45° FOV.
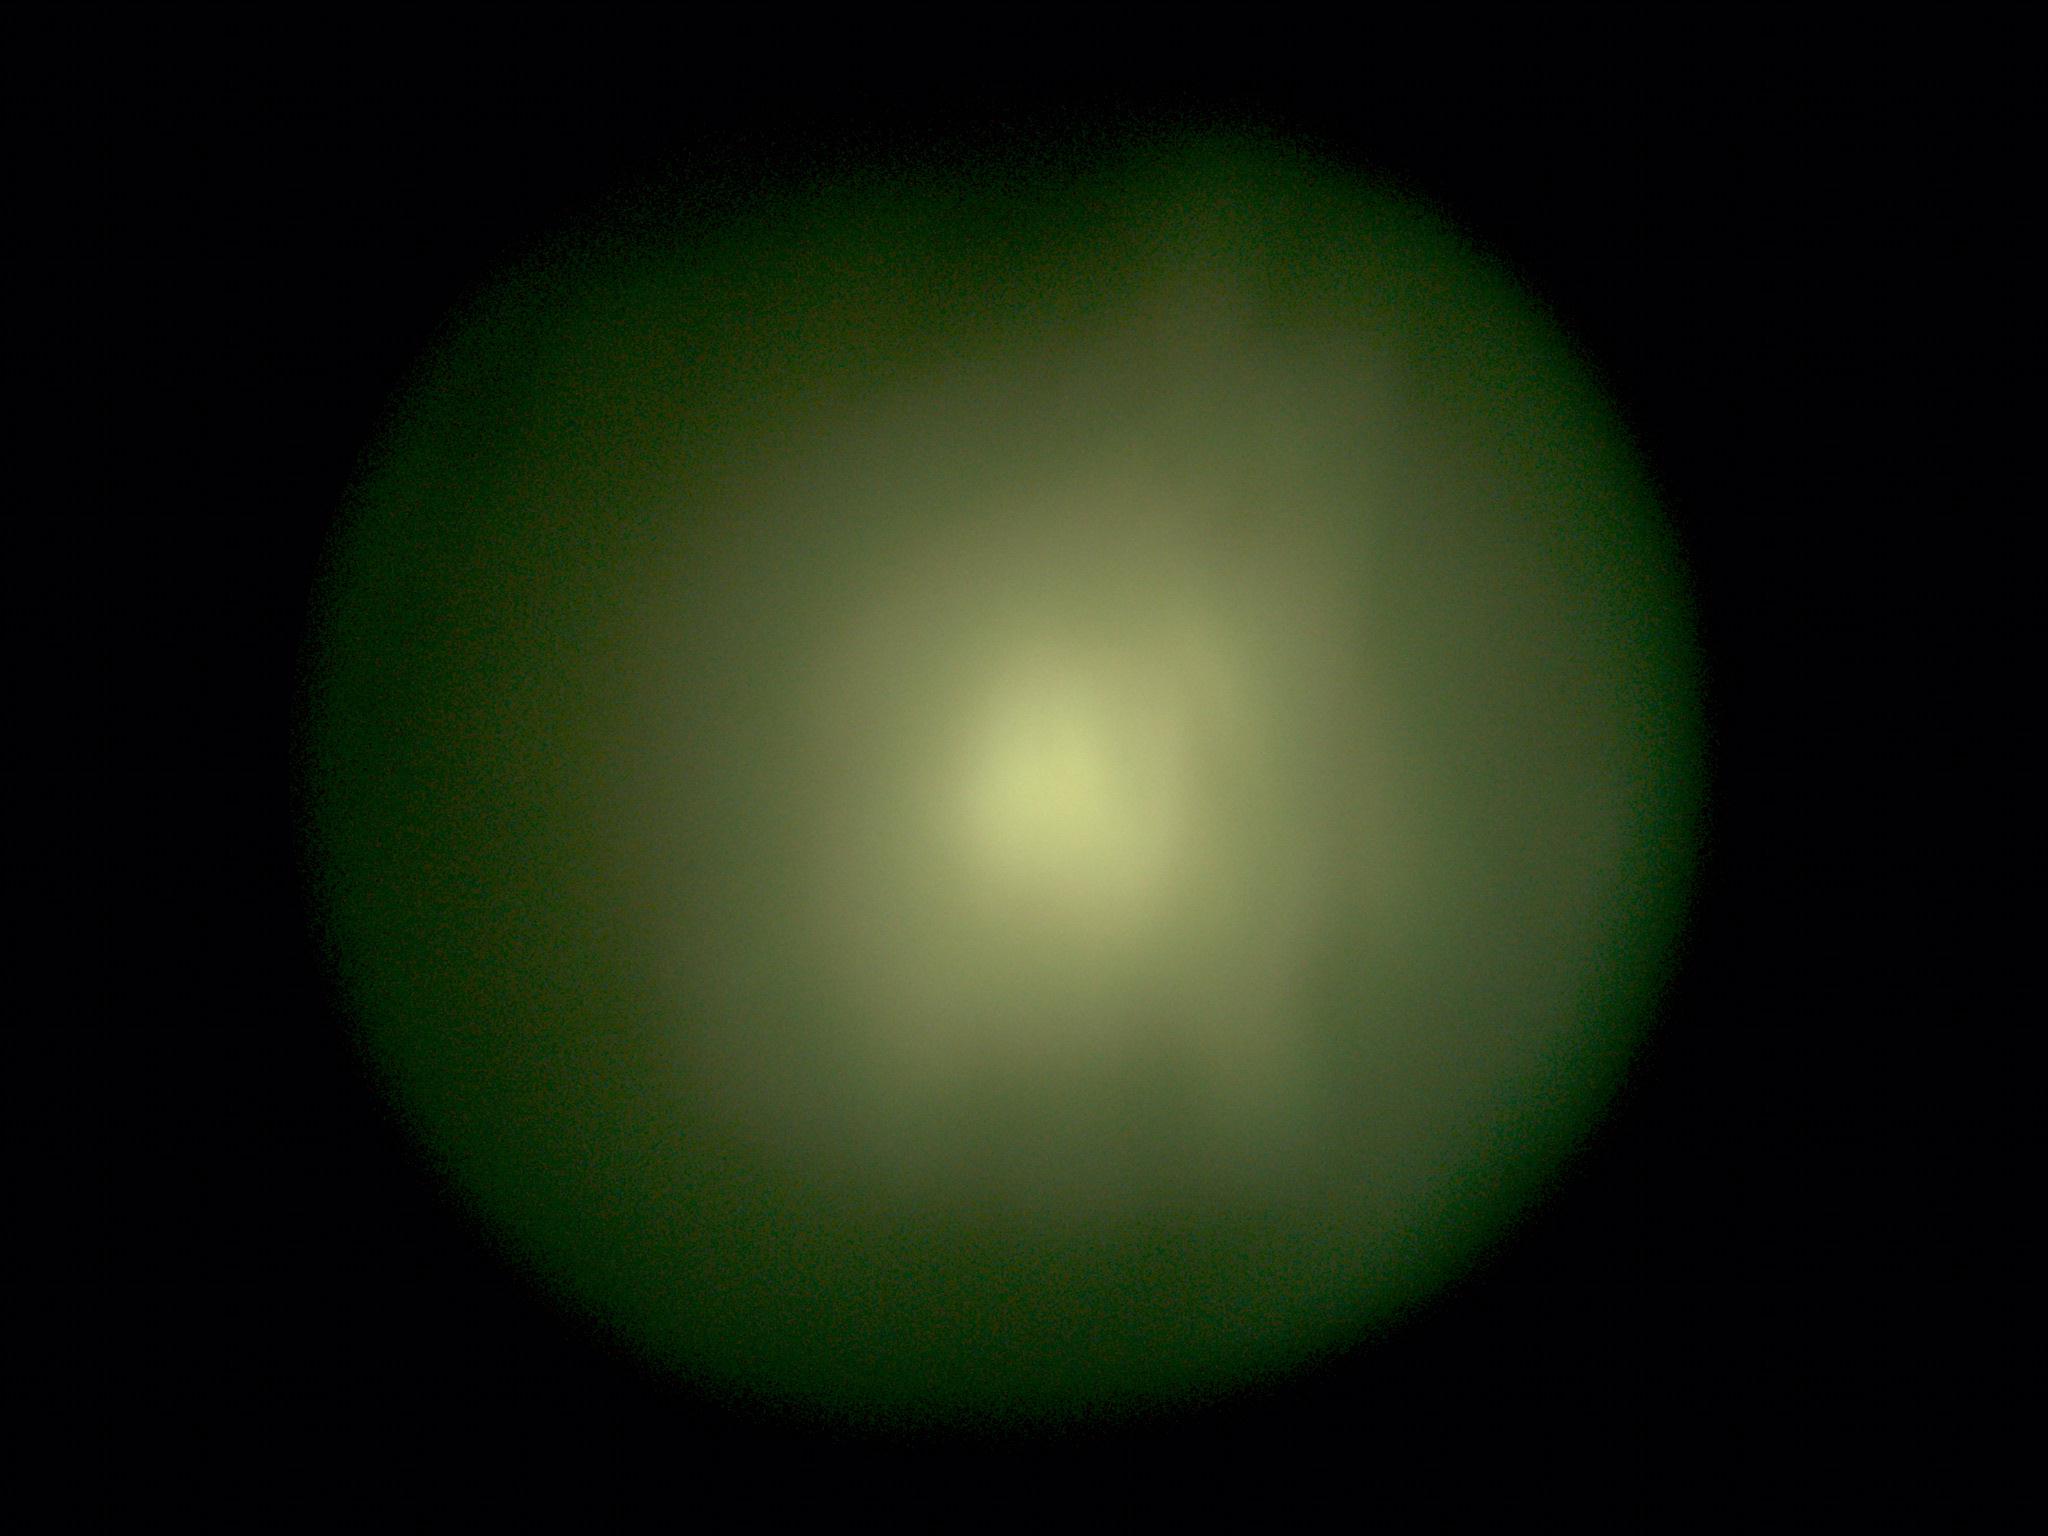 Quality too poor to assess for DR. DR stage is ungradable due to poor image quality.